Acquired on the Natus RetCam Envision; 1440 by 1080 pixels; infant wide-field fundus photograph: 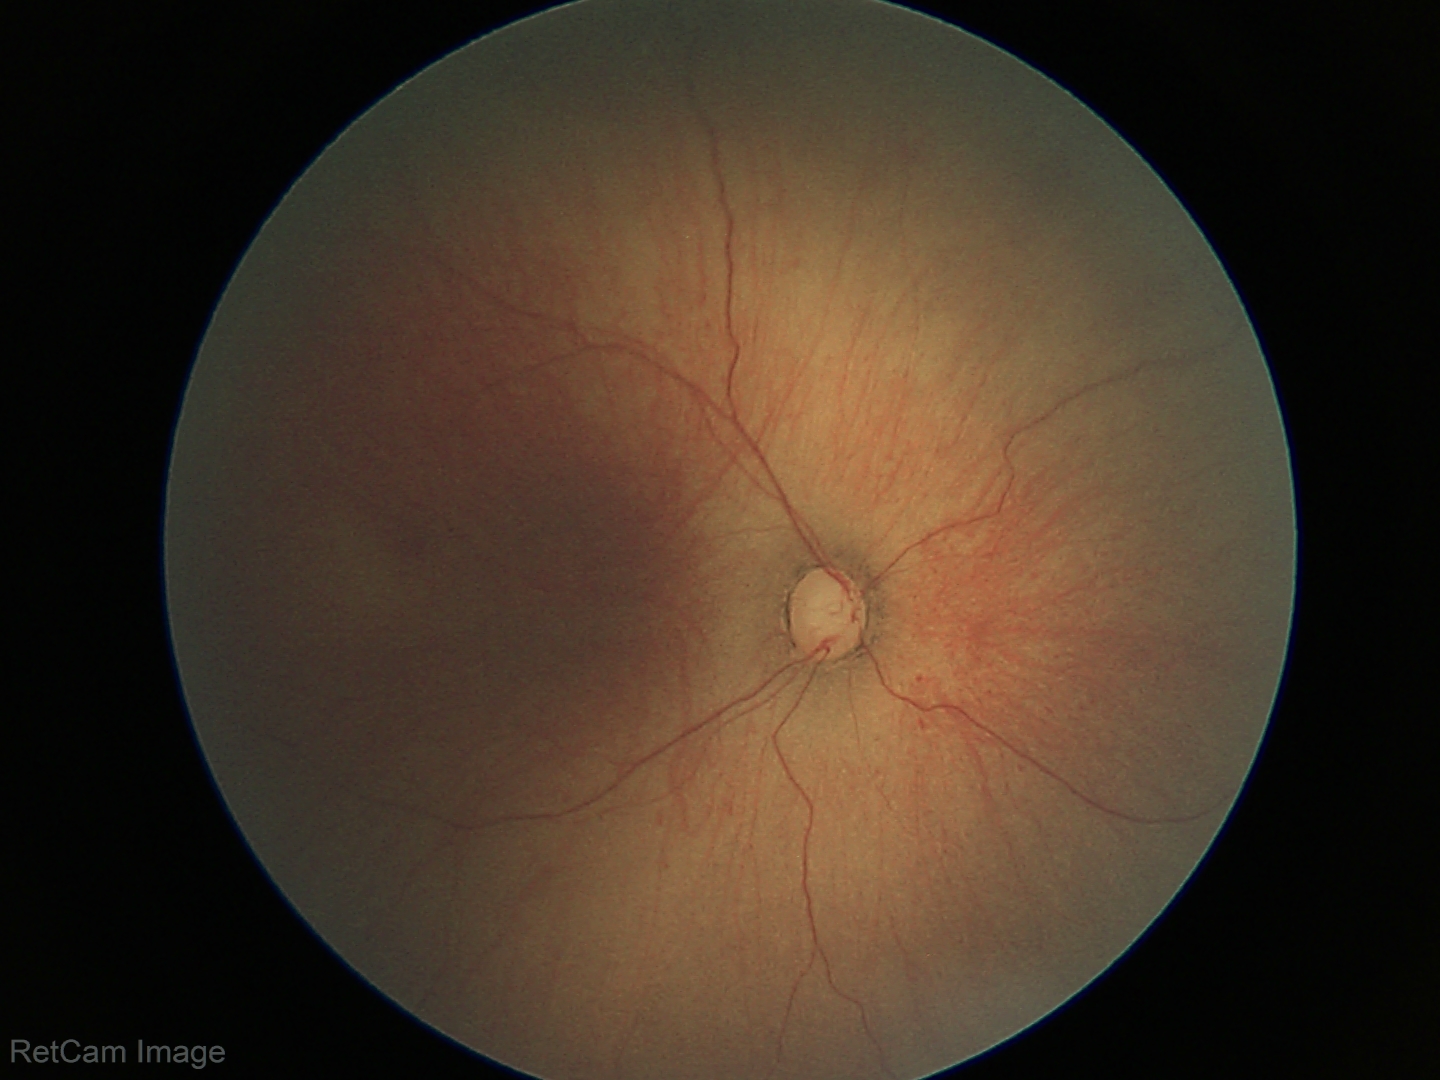

Examination diagnosed as ROP stage 1 — demarcation line between vascular and avascular retina. Without plus disease.